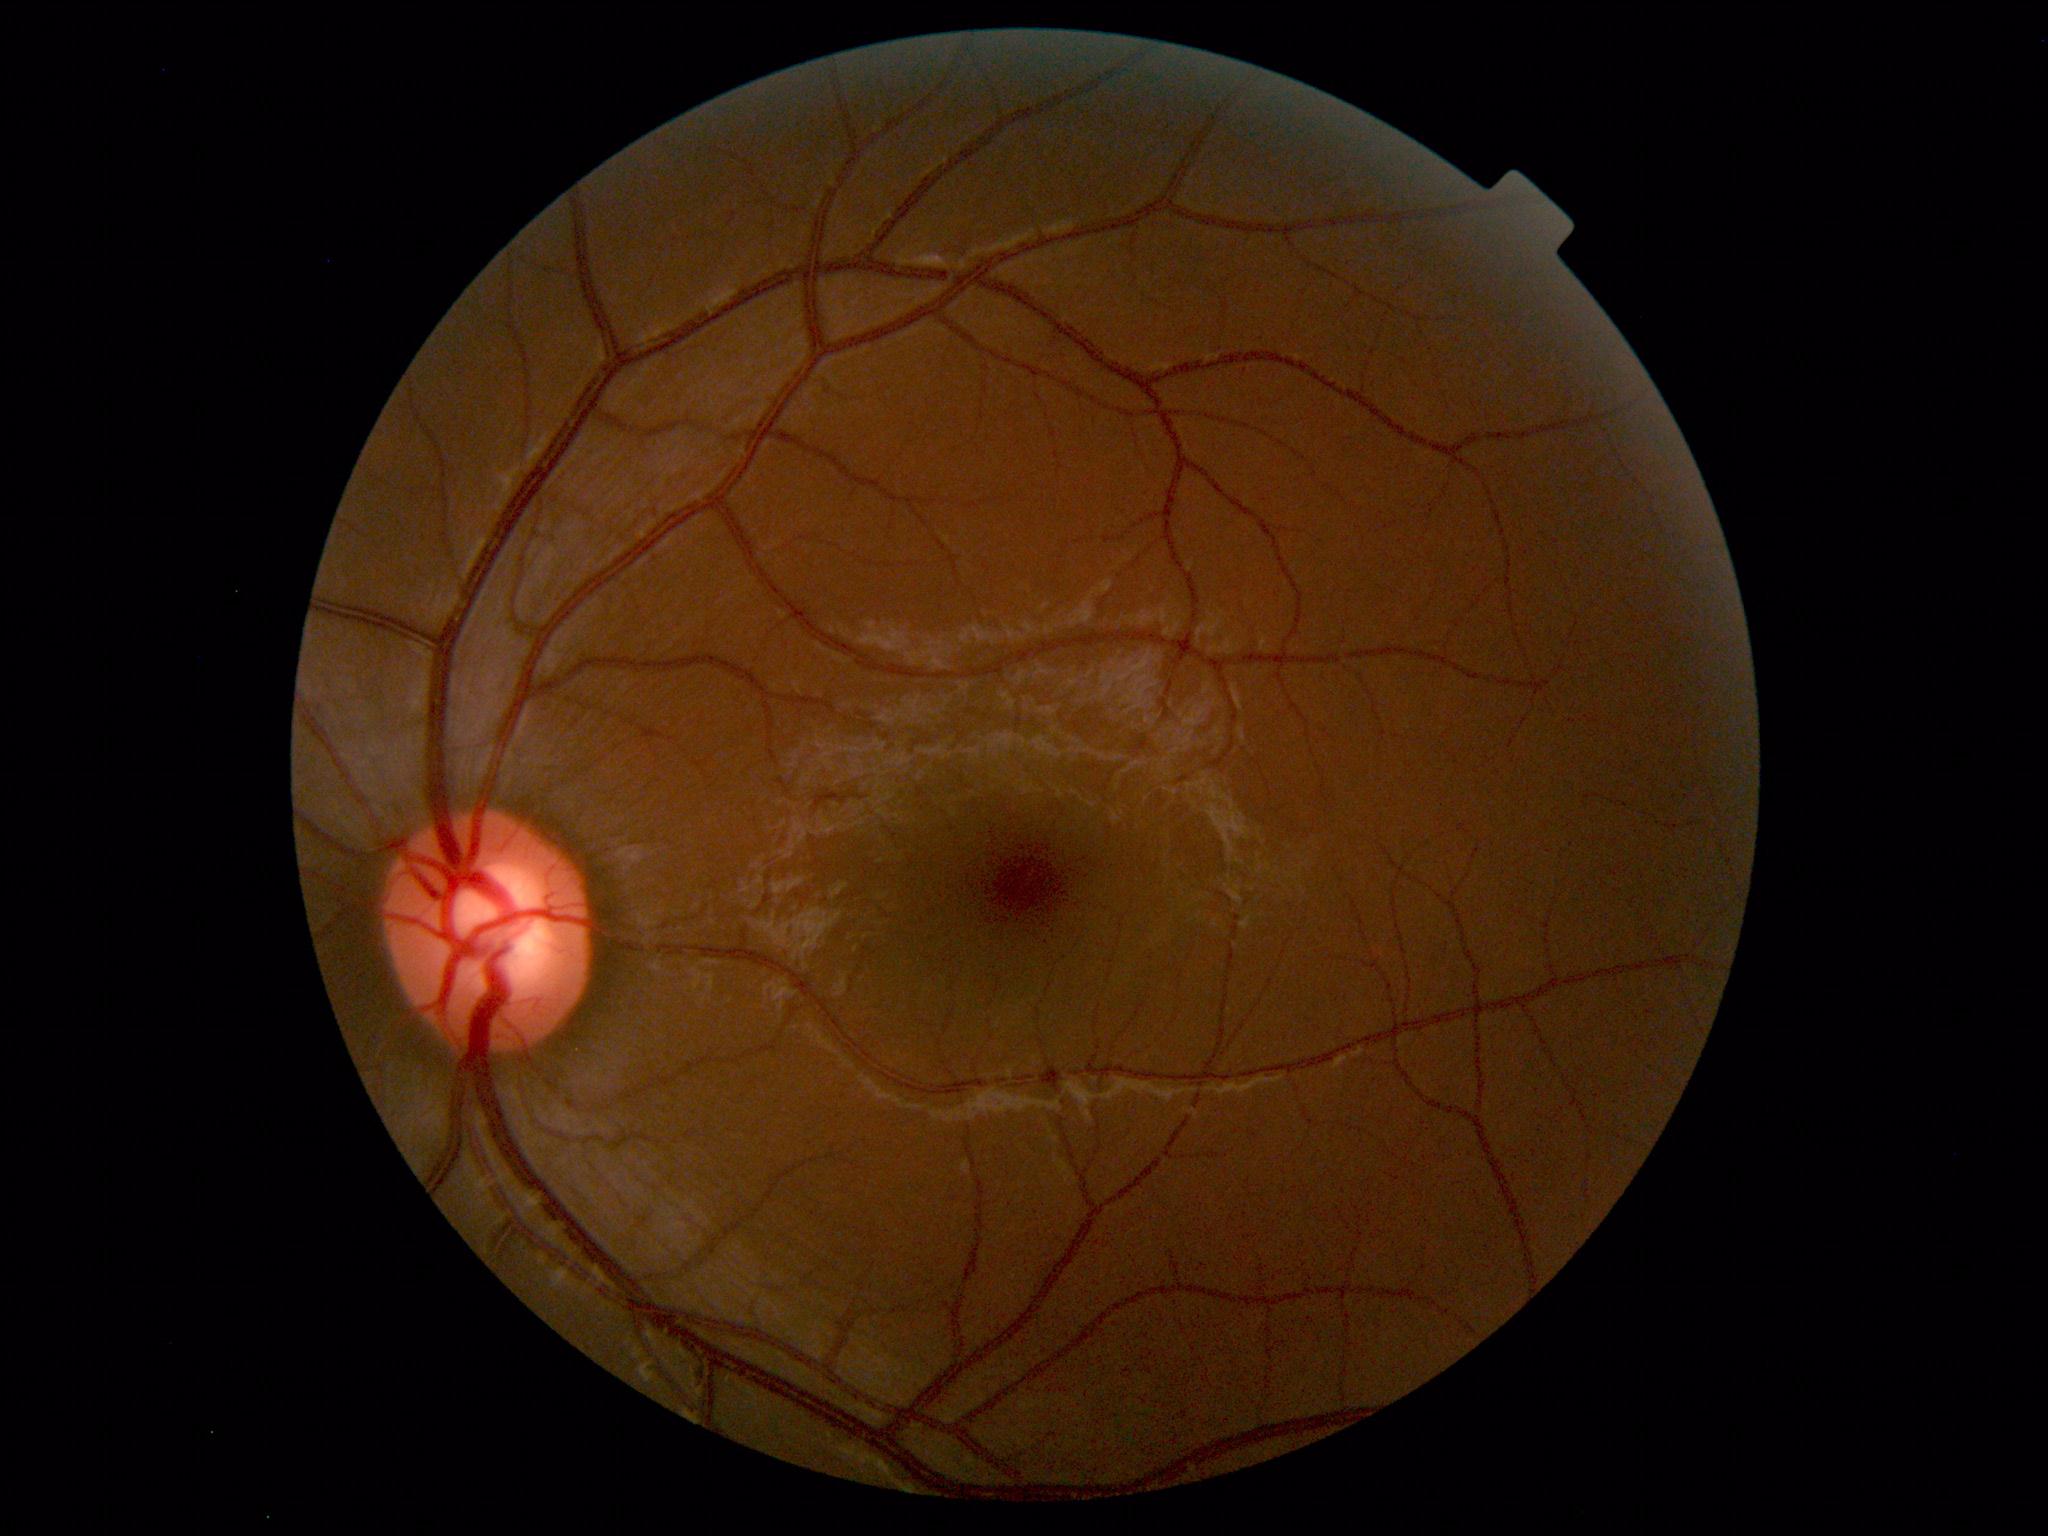 Diagnosis: normal.